Retinal fundus photograph · 2212 by 1659 pixels · 45° FOV — 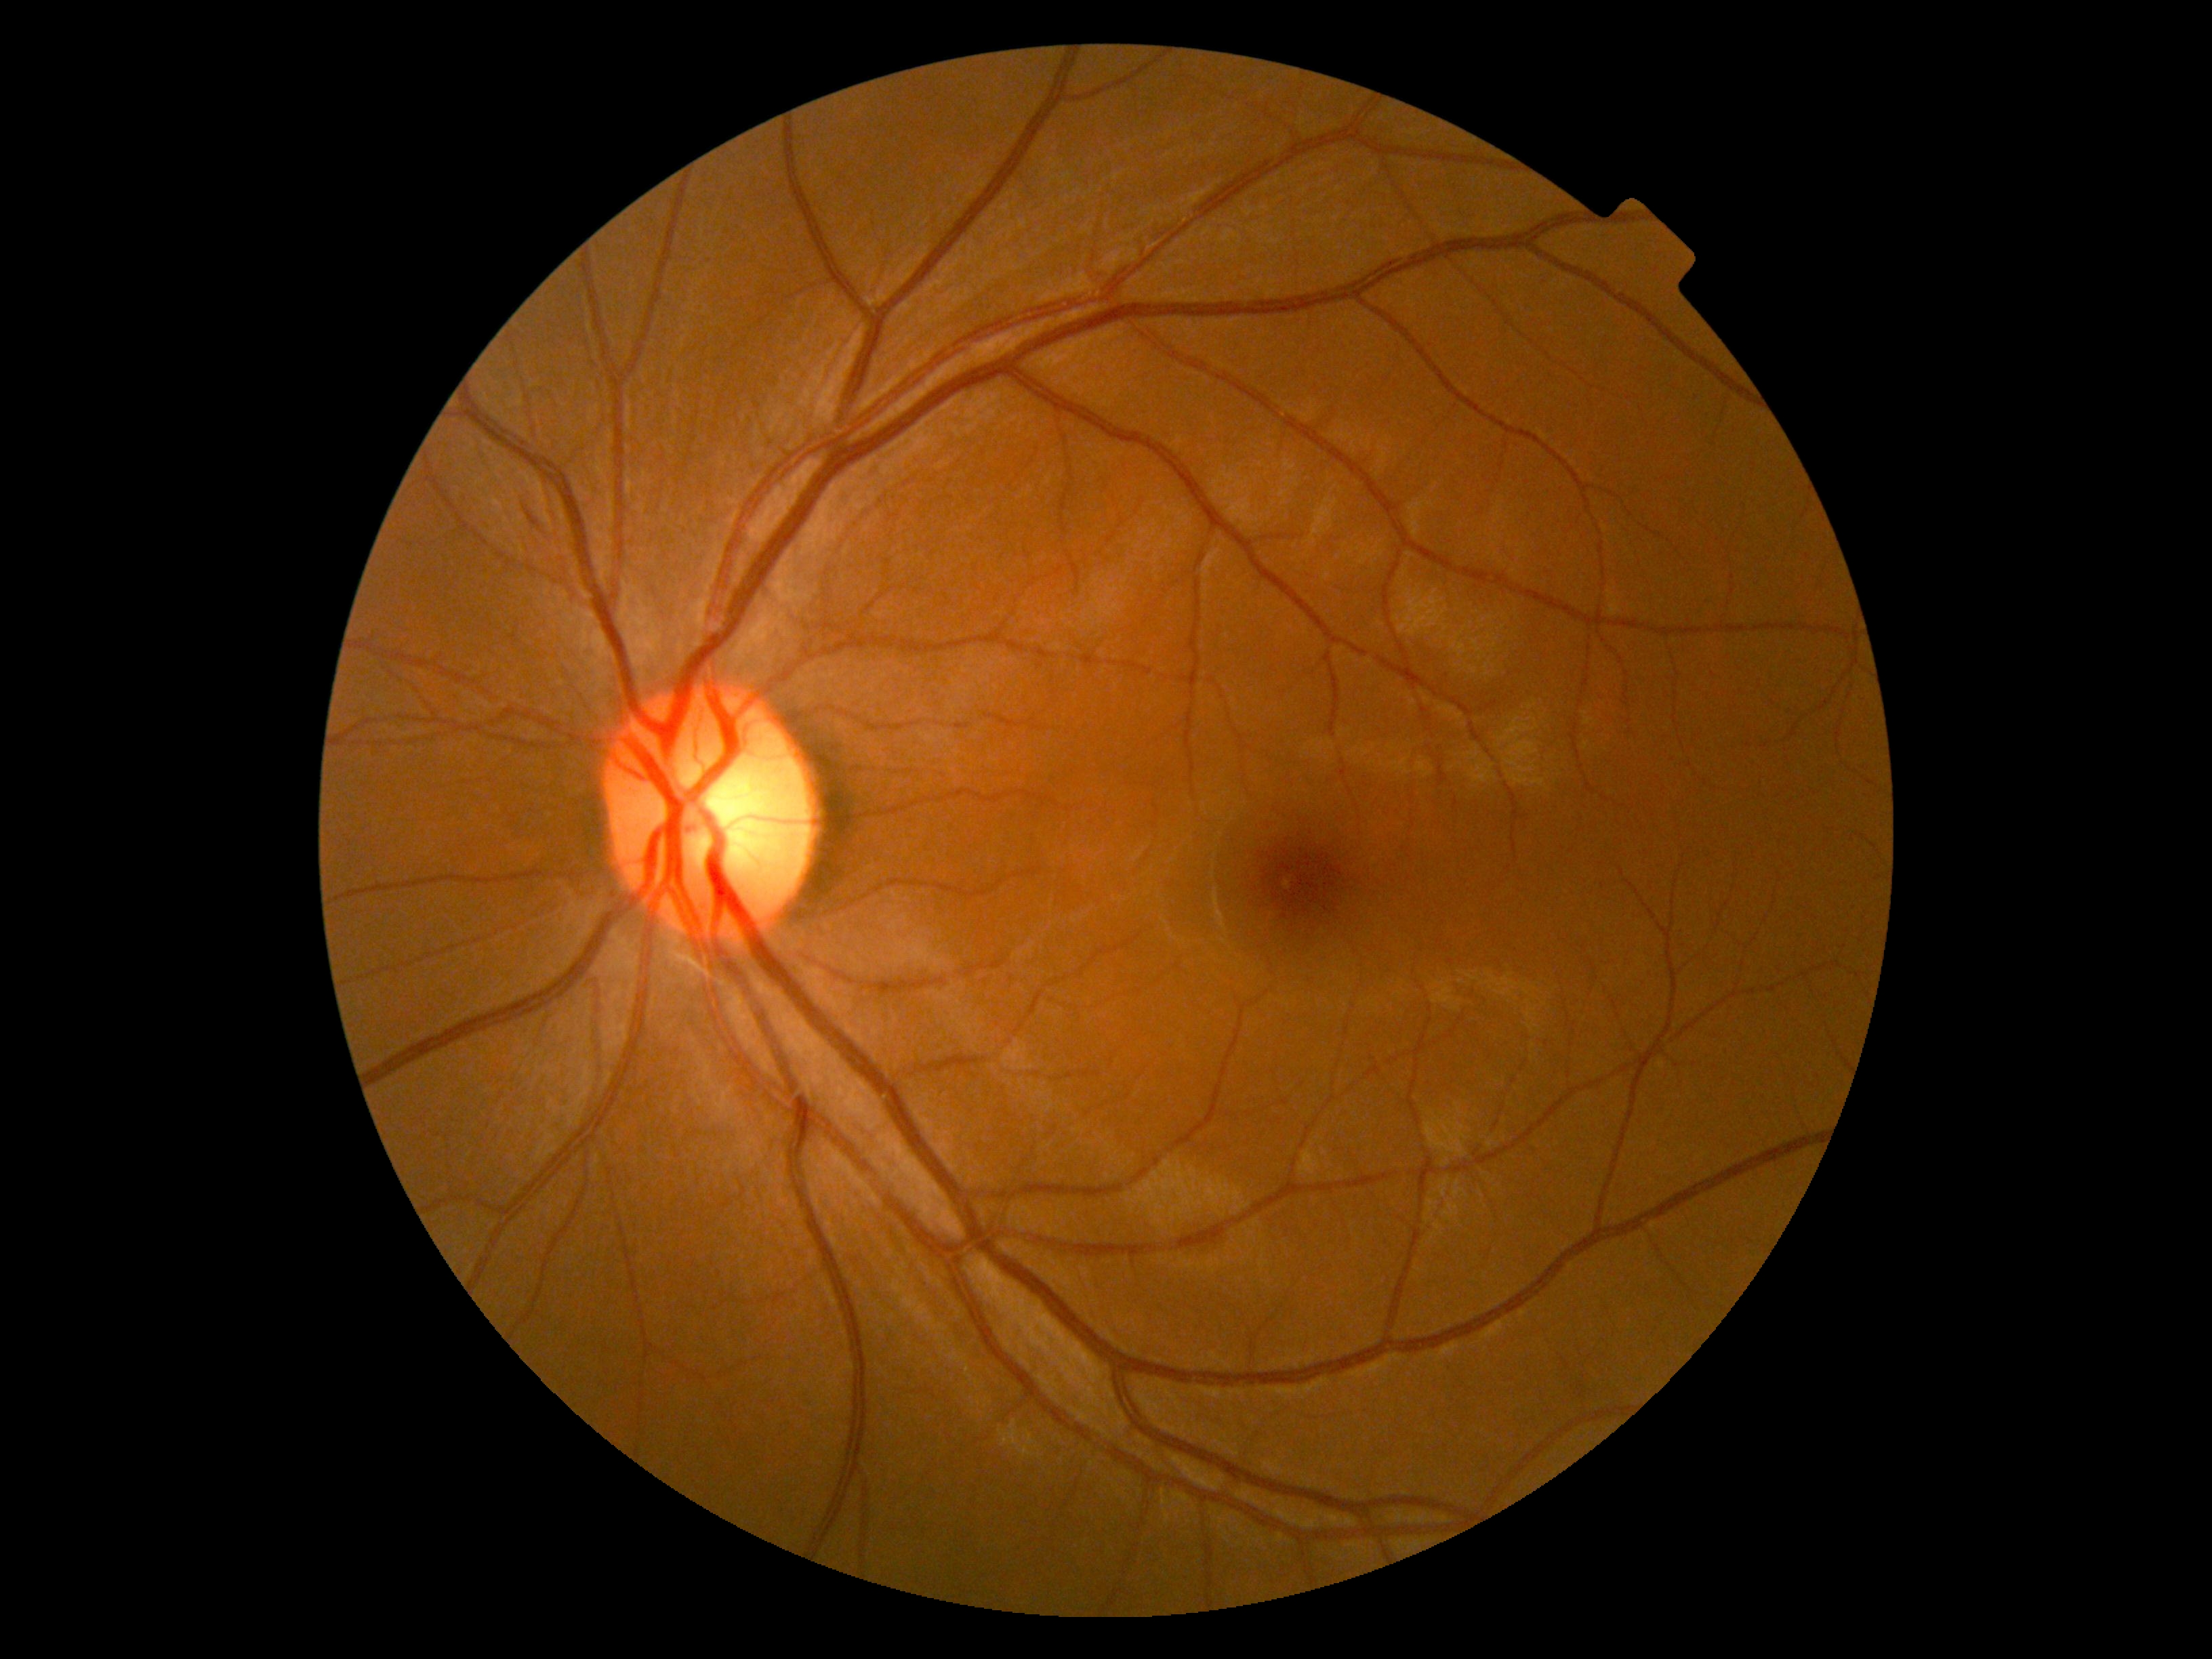

Retinopathy is grade 2 (moderate NPDR).